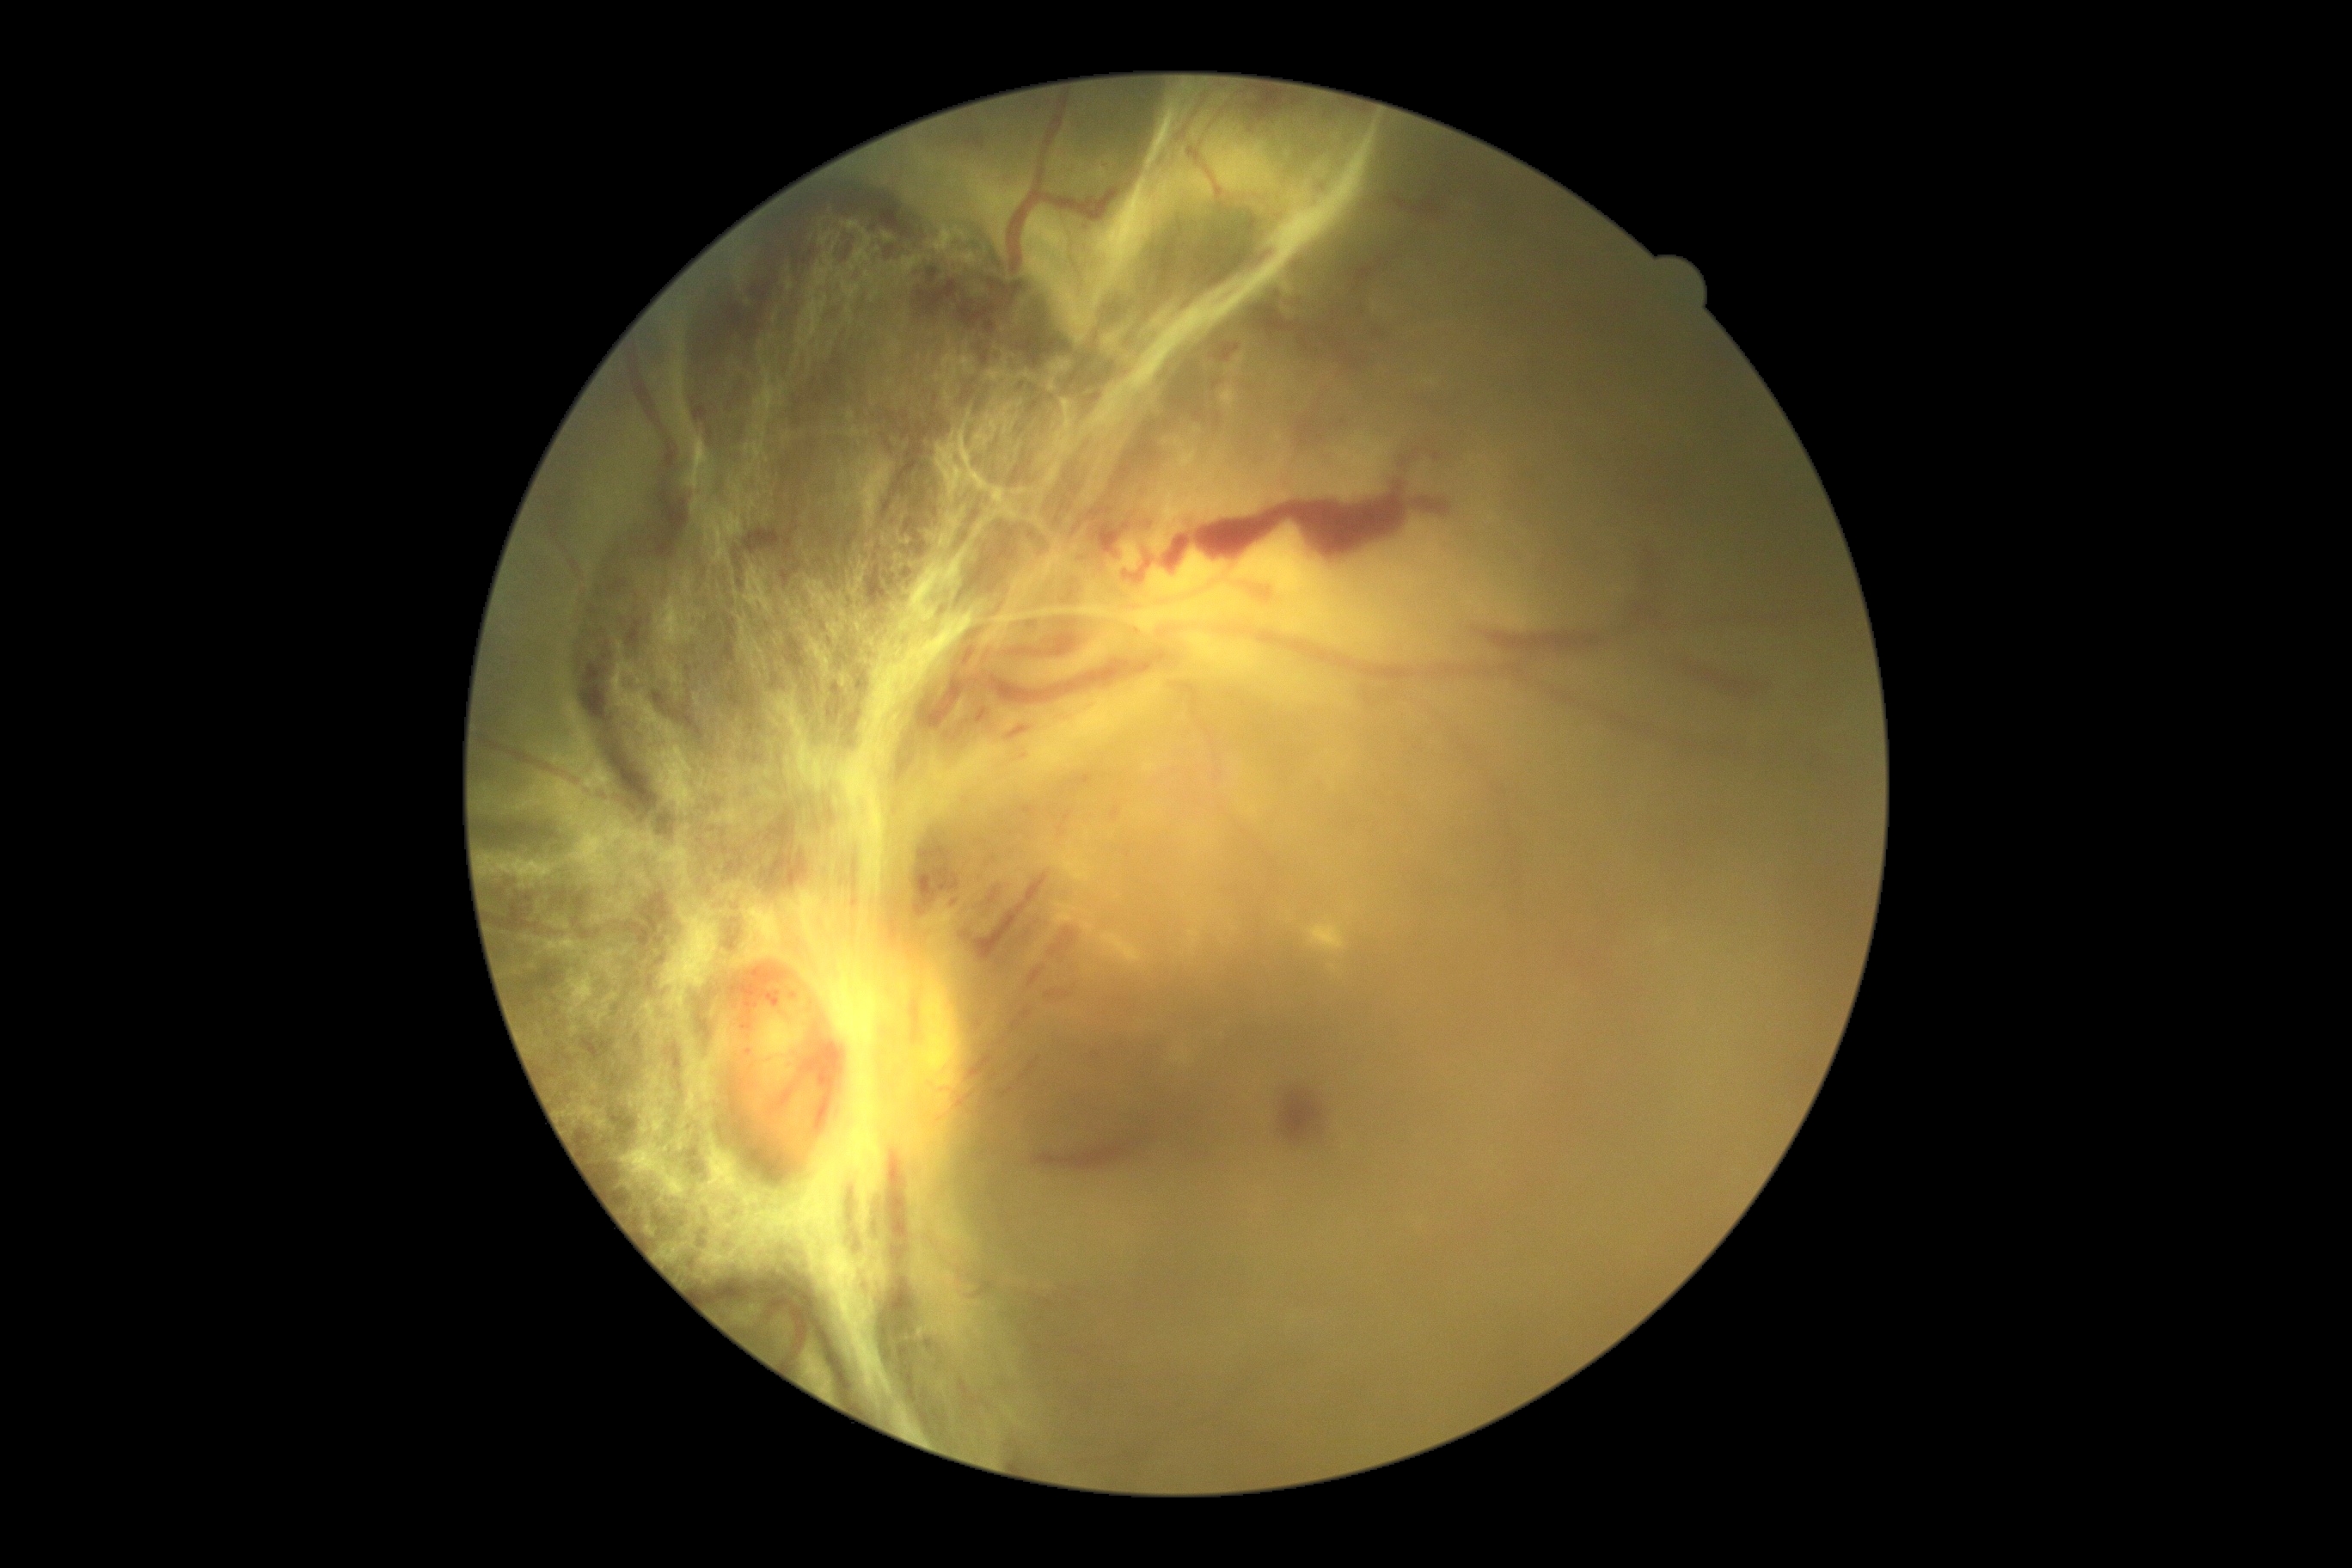
Diabetic retinopathy grade is PDR (4).